Wide-field contact fundus photograph of an infant.
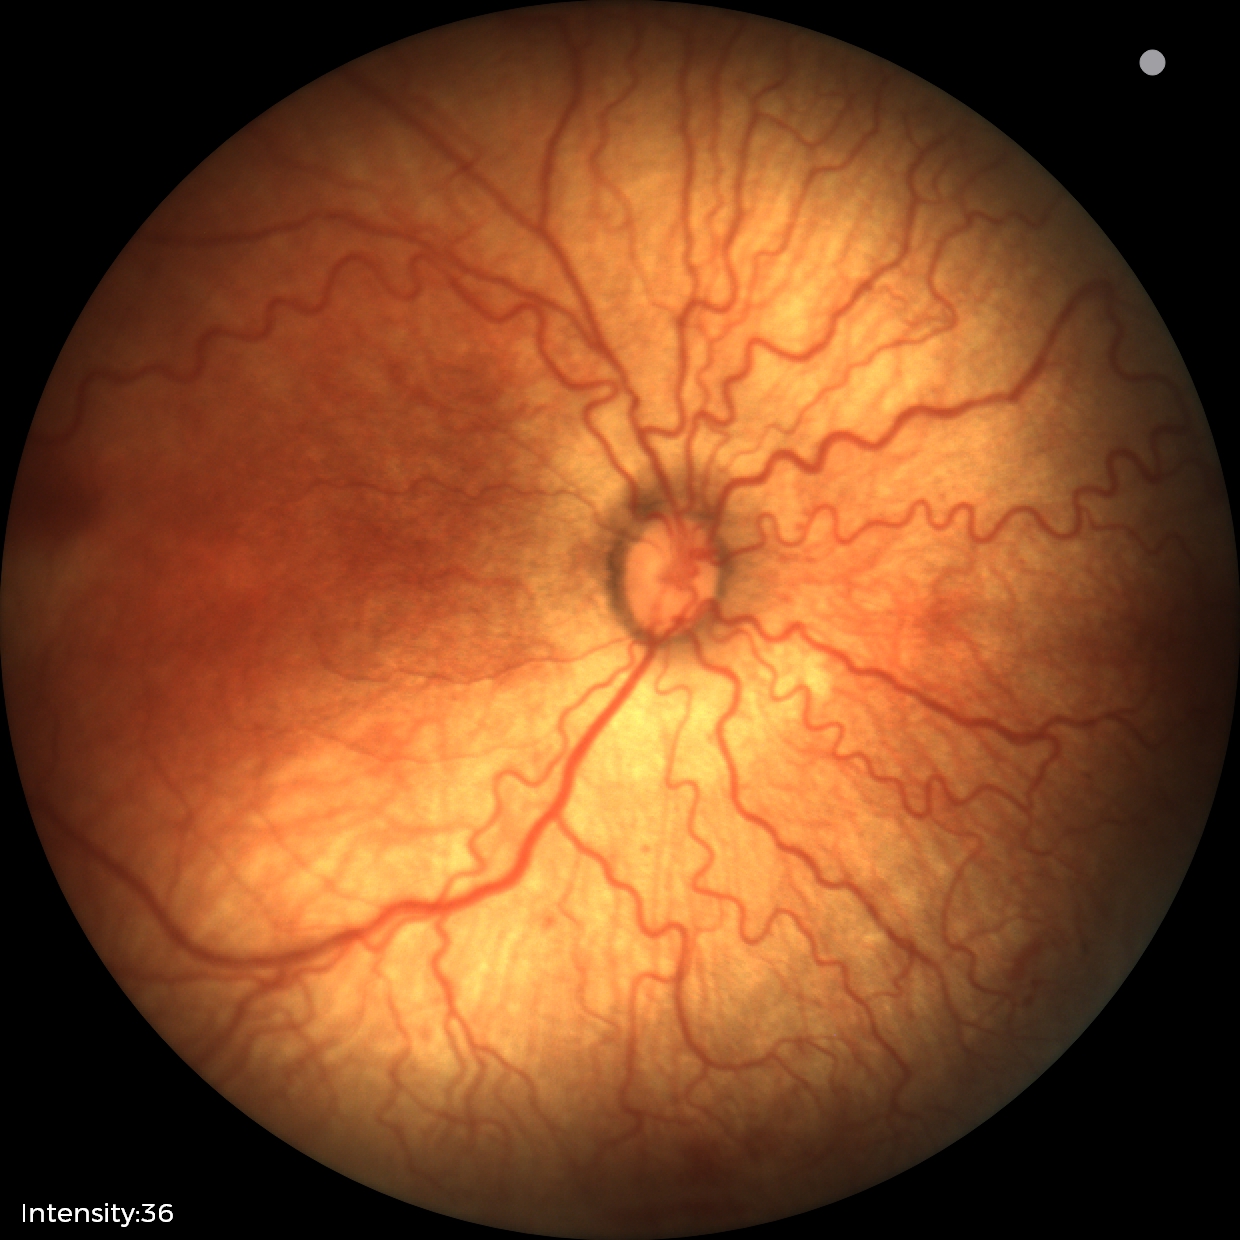 From an examination with diagnosis of retinopathy of prematurity (ROP) stage 2.
Plus disease was diagnosed.